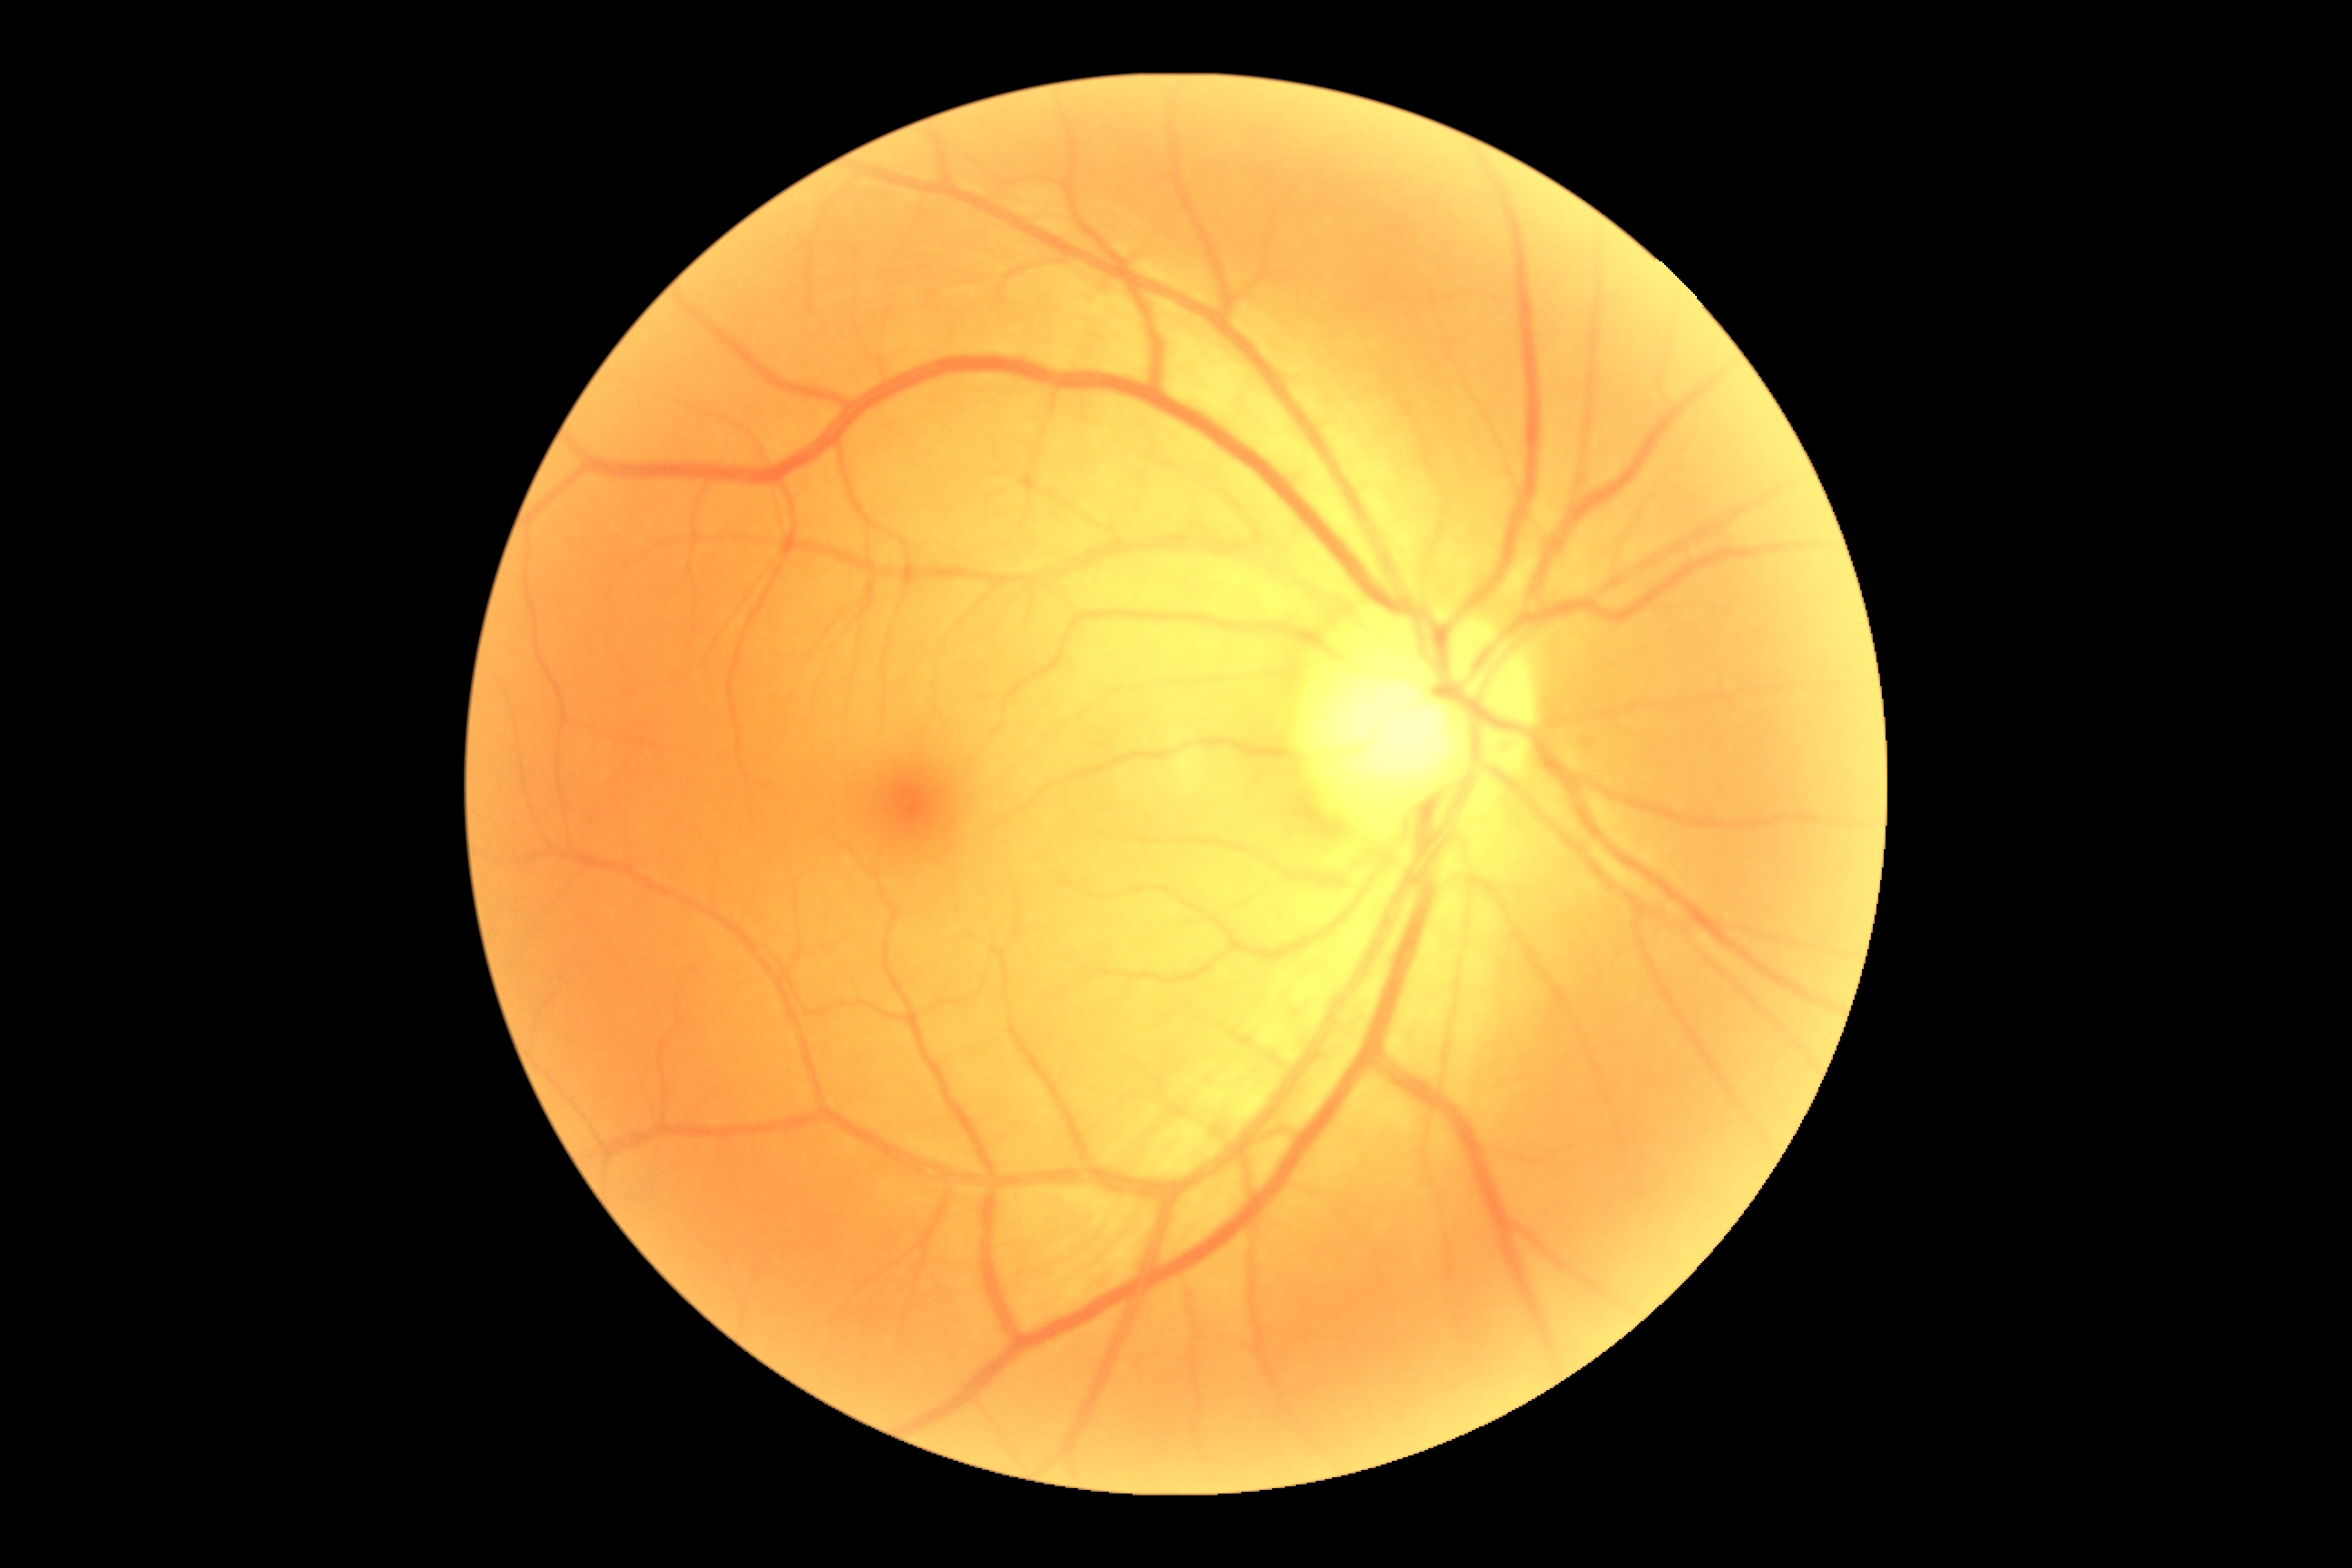

{
  "dr_impression": "negative for DR",
  "dr_grade": "0"
}